2048x1536px
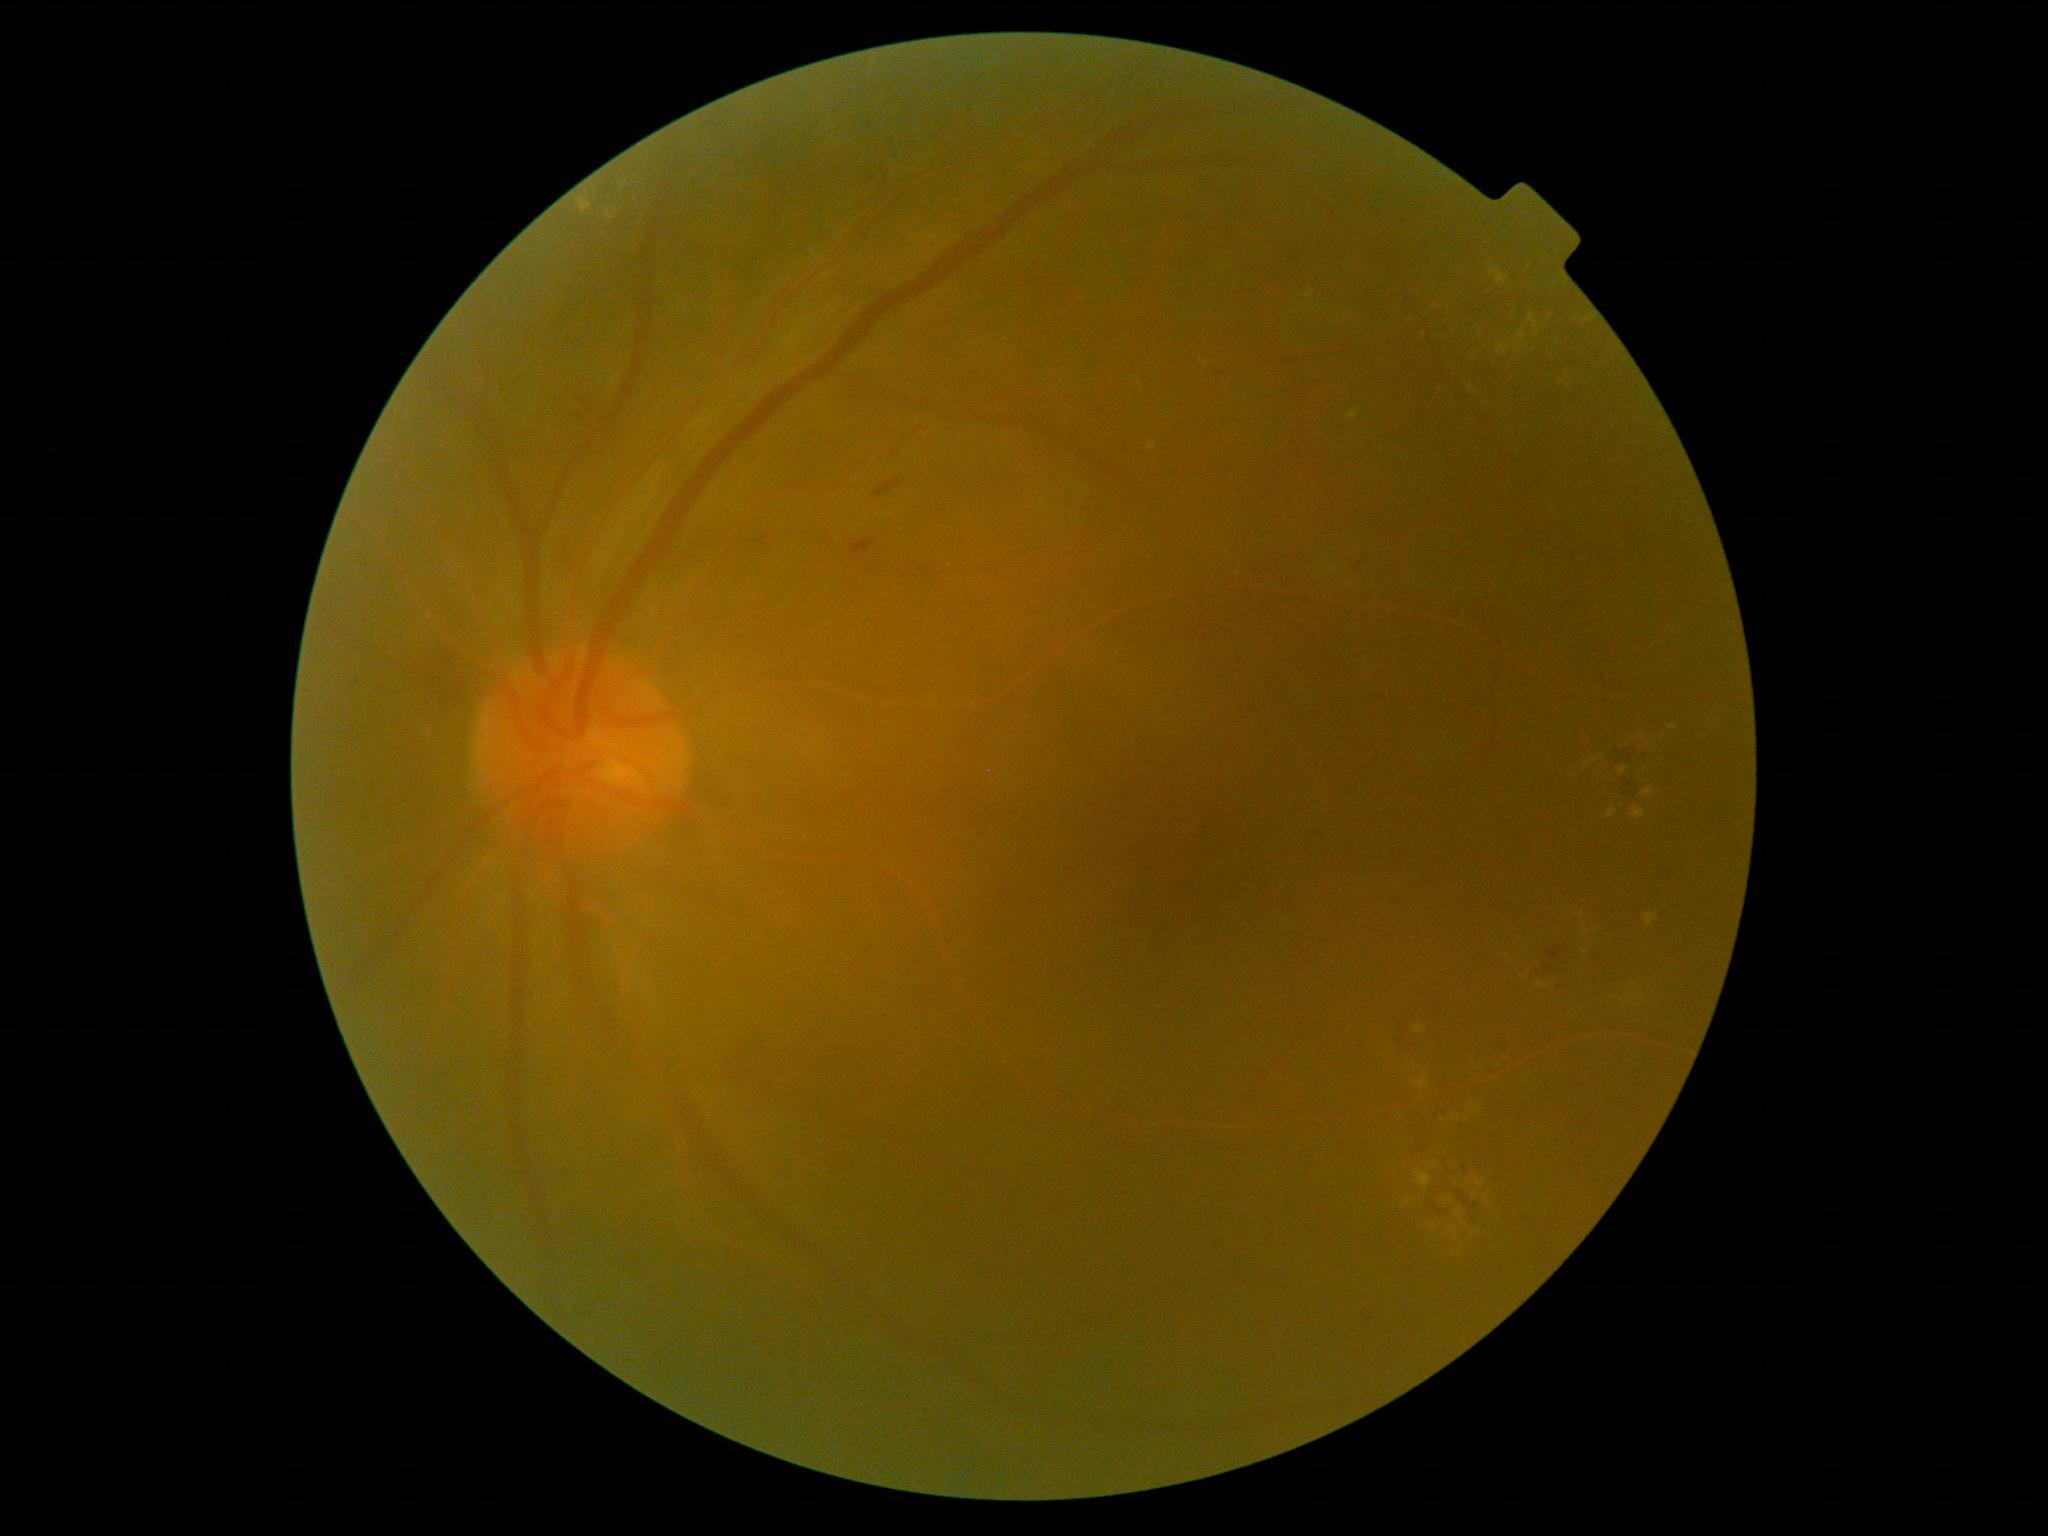

{"partial":true,"dr_grade":2,"lesions":{"ex":[[1434,1210,1493,1257],[1350,411,1360,420],[1607,809,1618,819],[1414,1025,1426,1034],[1668,727,1677,734],[1632,806,1647,820],[1496,271,1508,285],[1578,313,1594,324],[1542,308,1551,321],[1620,767,1628,774],[1305,291,1314,300],[1647,915,1658,926]],"ex_small_centers":[[1542,985],[1550,986]],"se":null,"he":[[1539,943,1565,975],[852,541,875,554],[875,480,904,498],[1424,1201,1453,1216],[1609,746,1642,760],[1622,781,1639,796],[1460,1194,1482,1222],[1488,1039,1512,1055],[1657,862,1672,879]],"ma":null}}